Color fundus image:
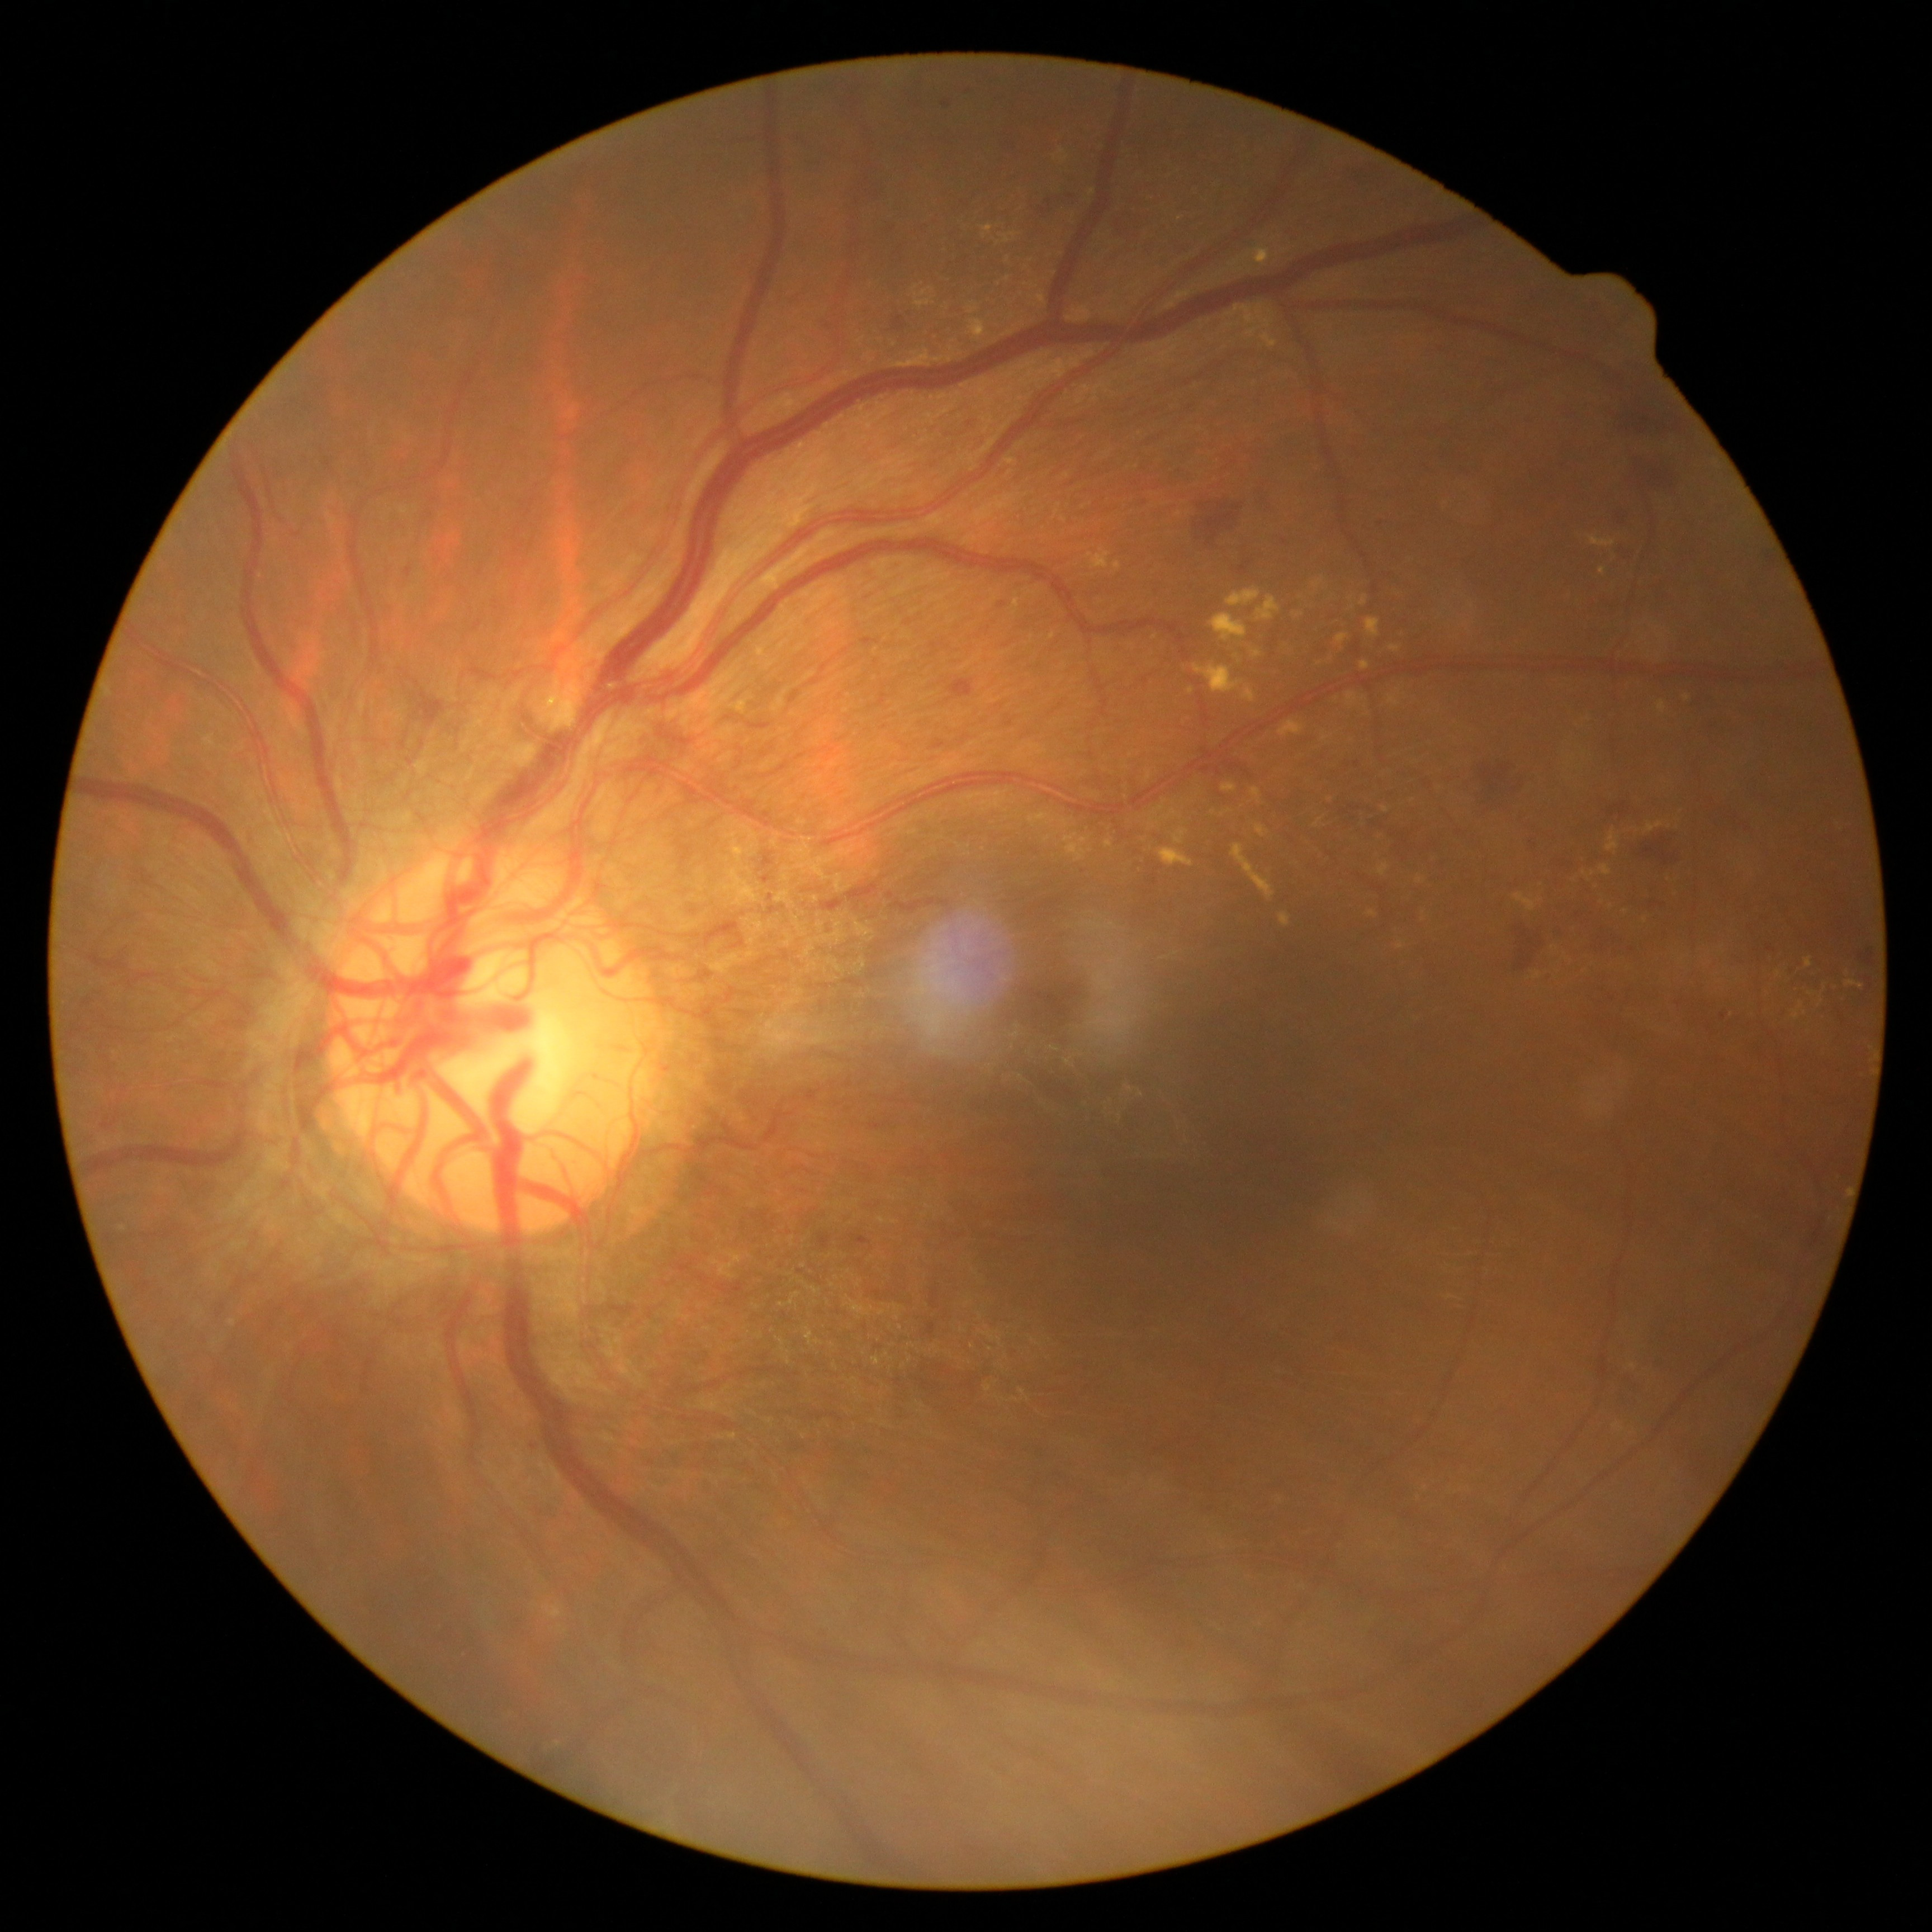
diabetic retinopathy = proliferative diabetic retinopathy (grade 4)